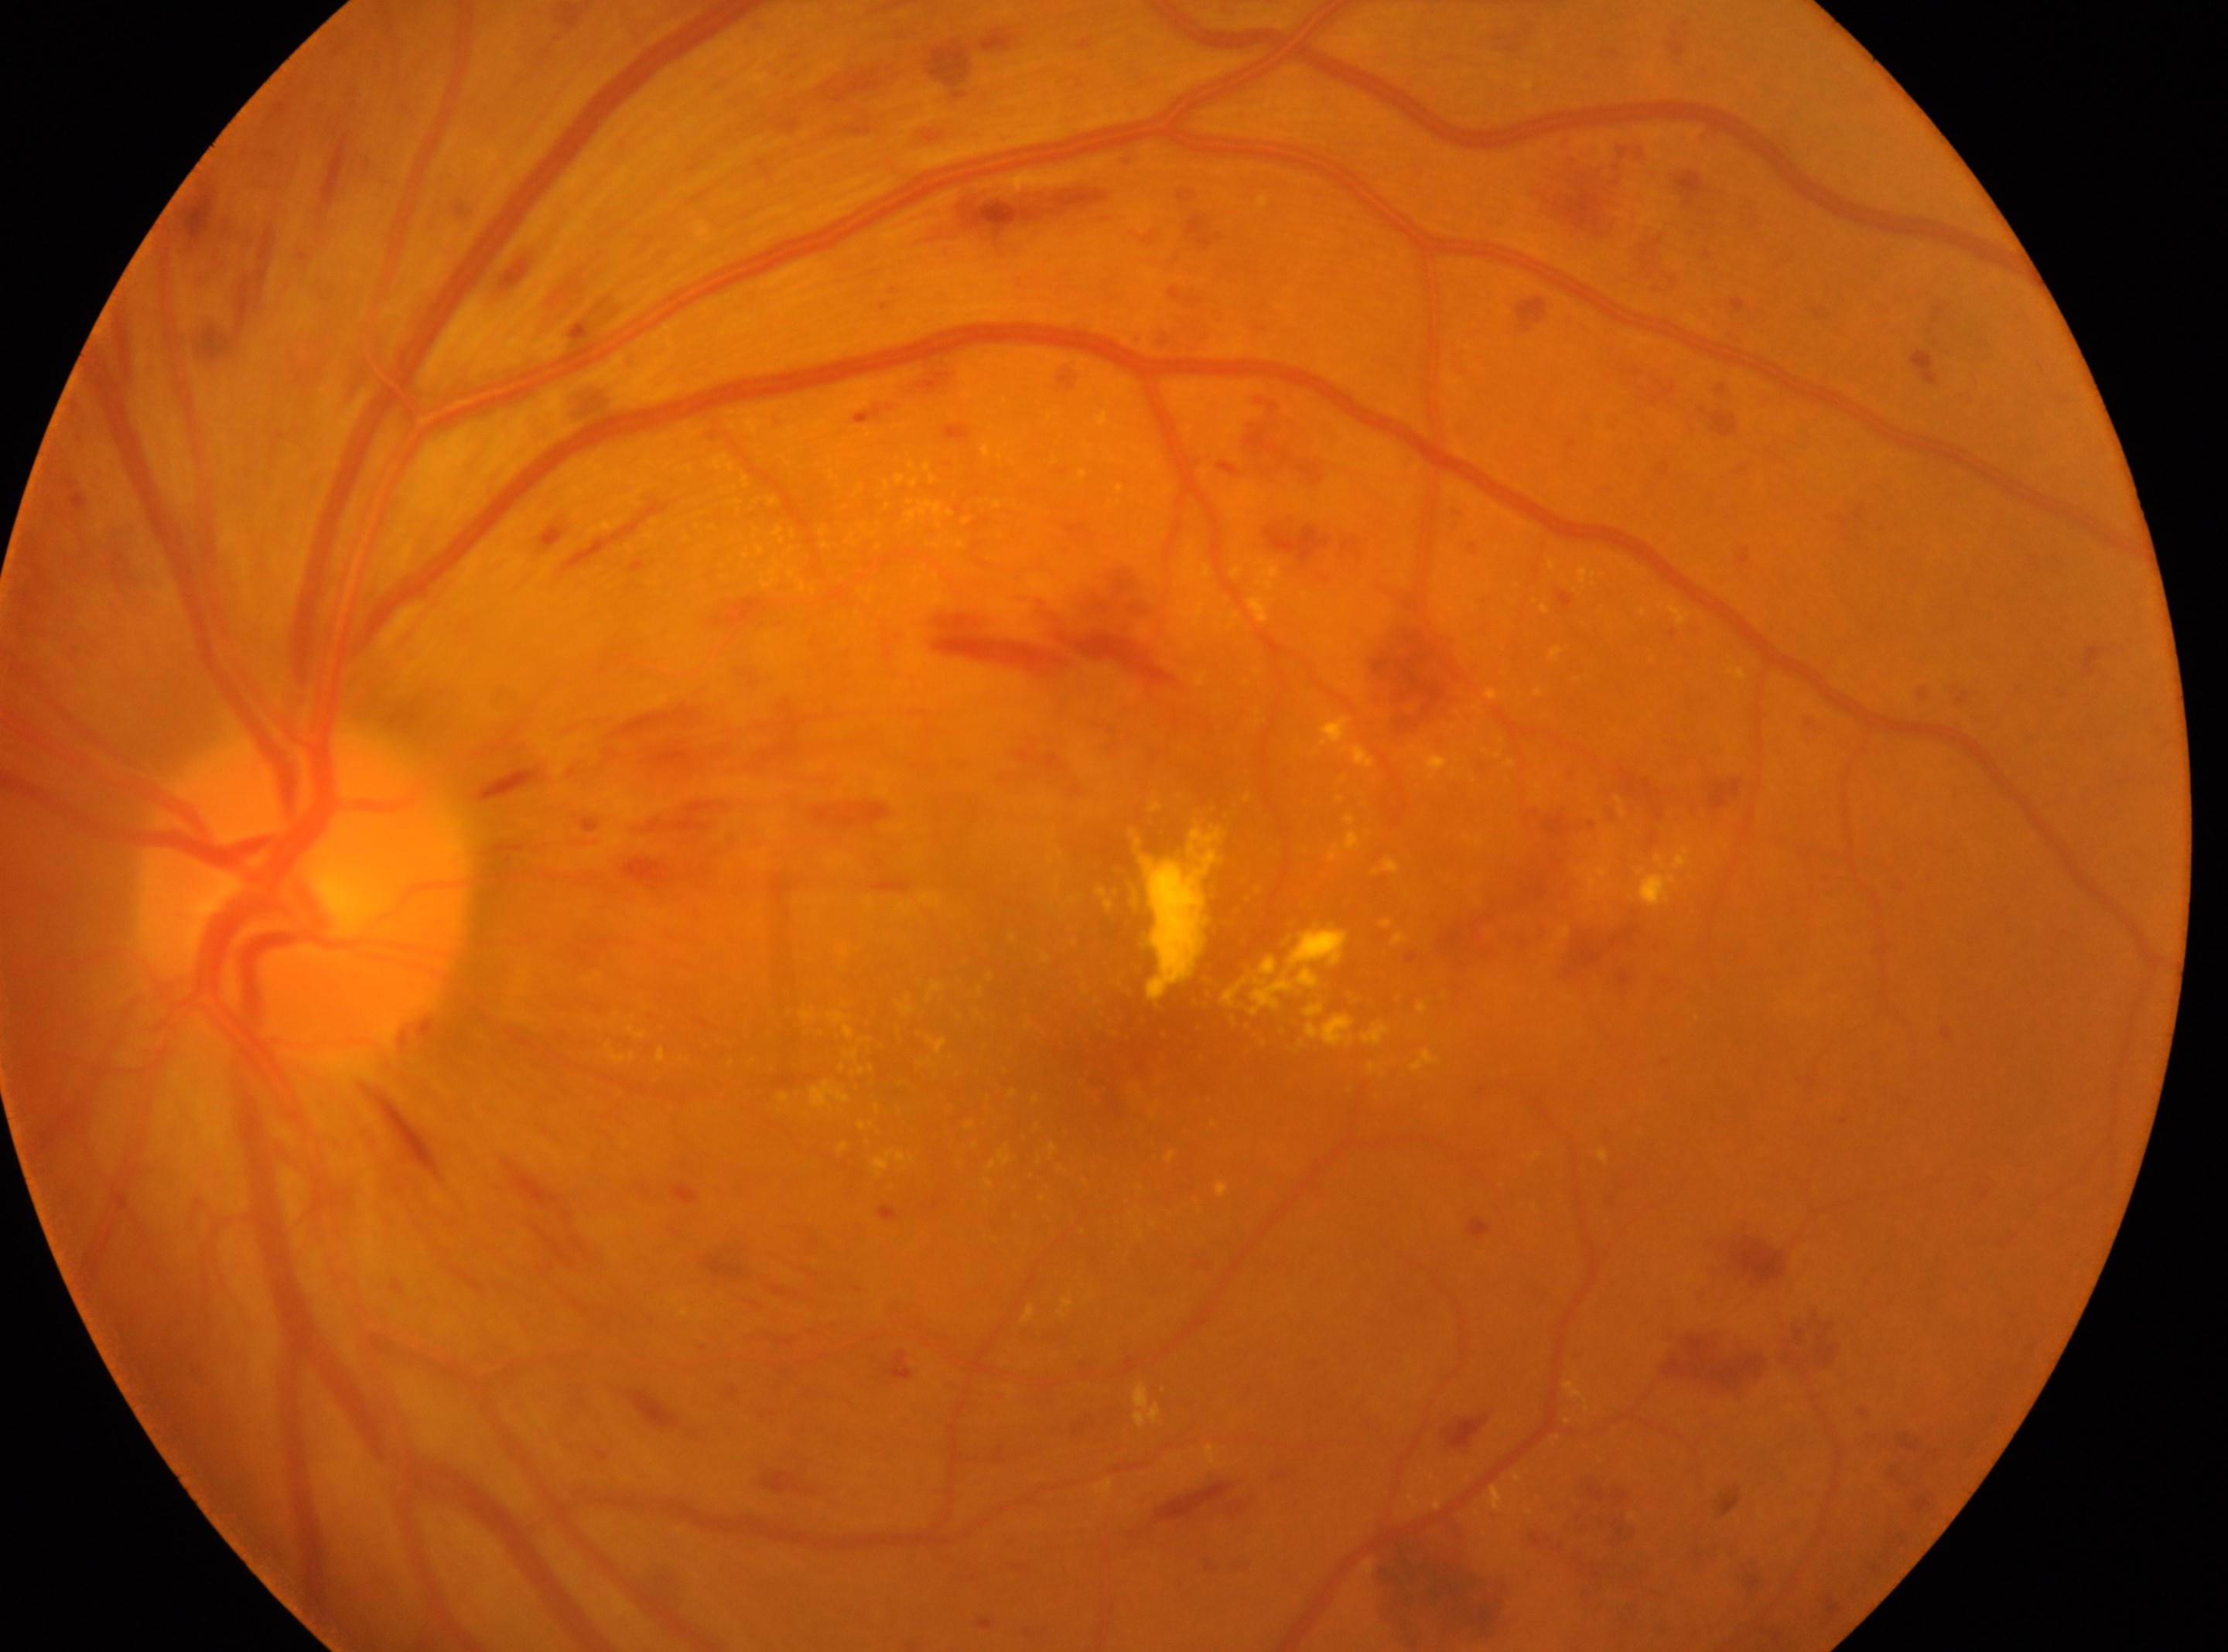

Fovea located at (1086, 1066). DR grade: 3 — more than 20 intraretinal hemorrhages in each of 4 quadrants, definite venous beading in 2 or more quadrants, or prominent intraretinal microvascular abnormalities in 1 or more quadrants, with no signs of proliferative retinopathy. Optic disk: (305, 889). Eye: left.